2184x1690px.
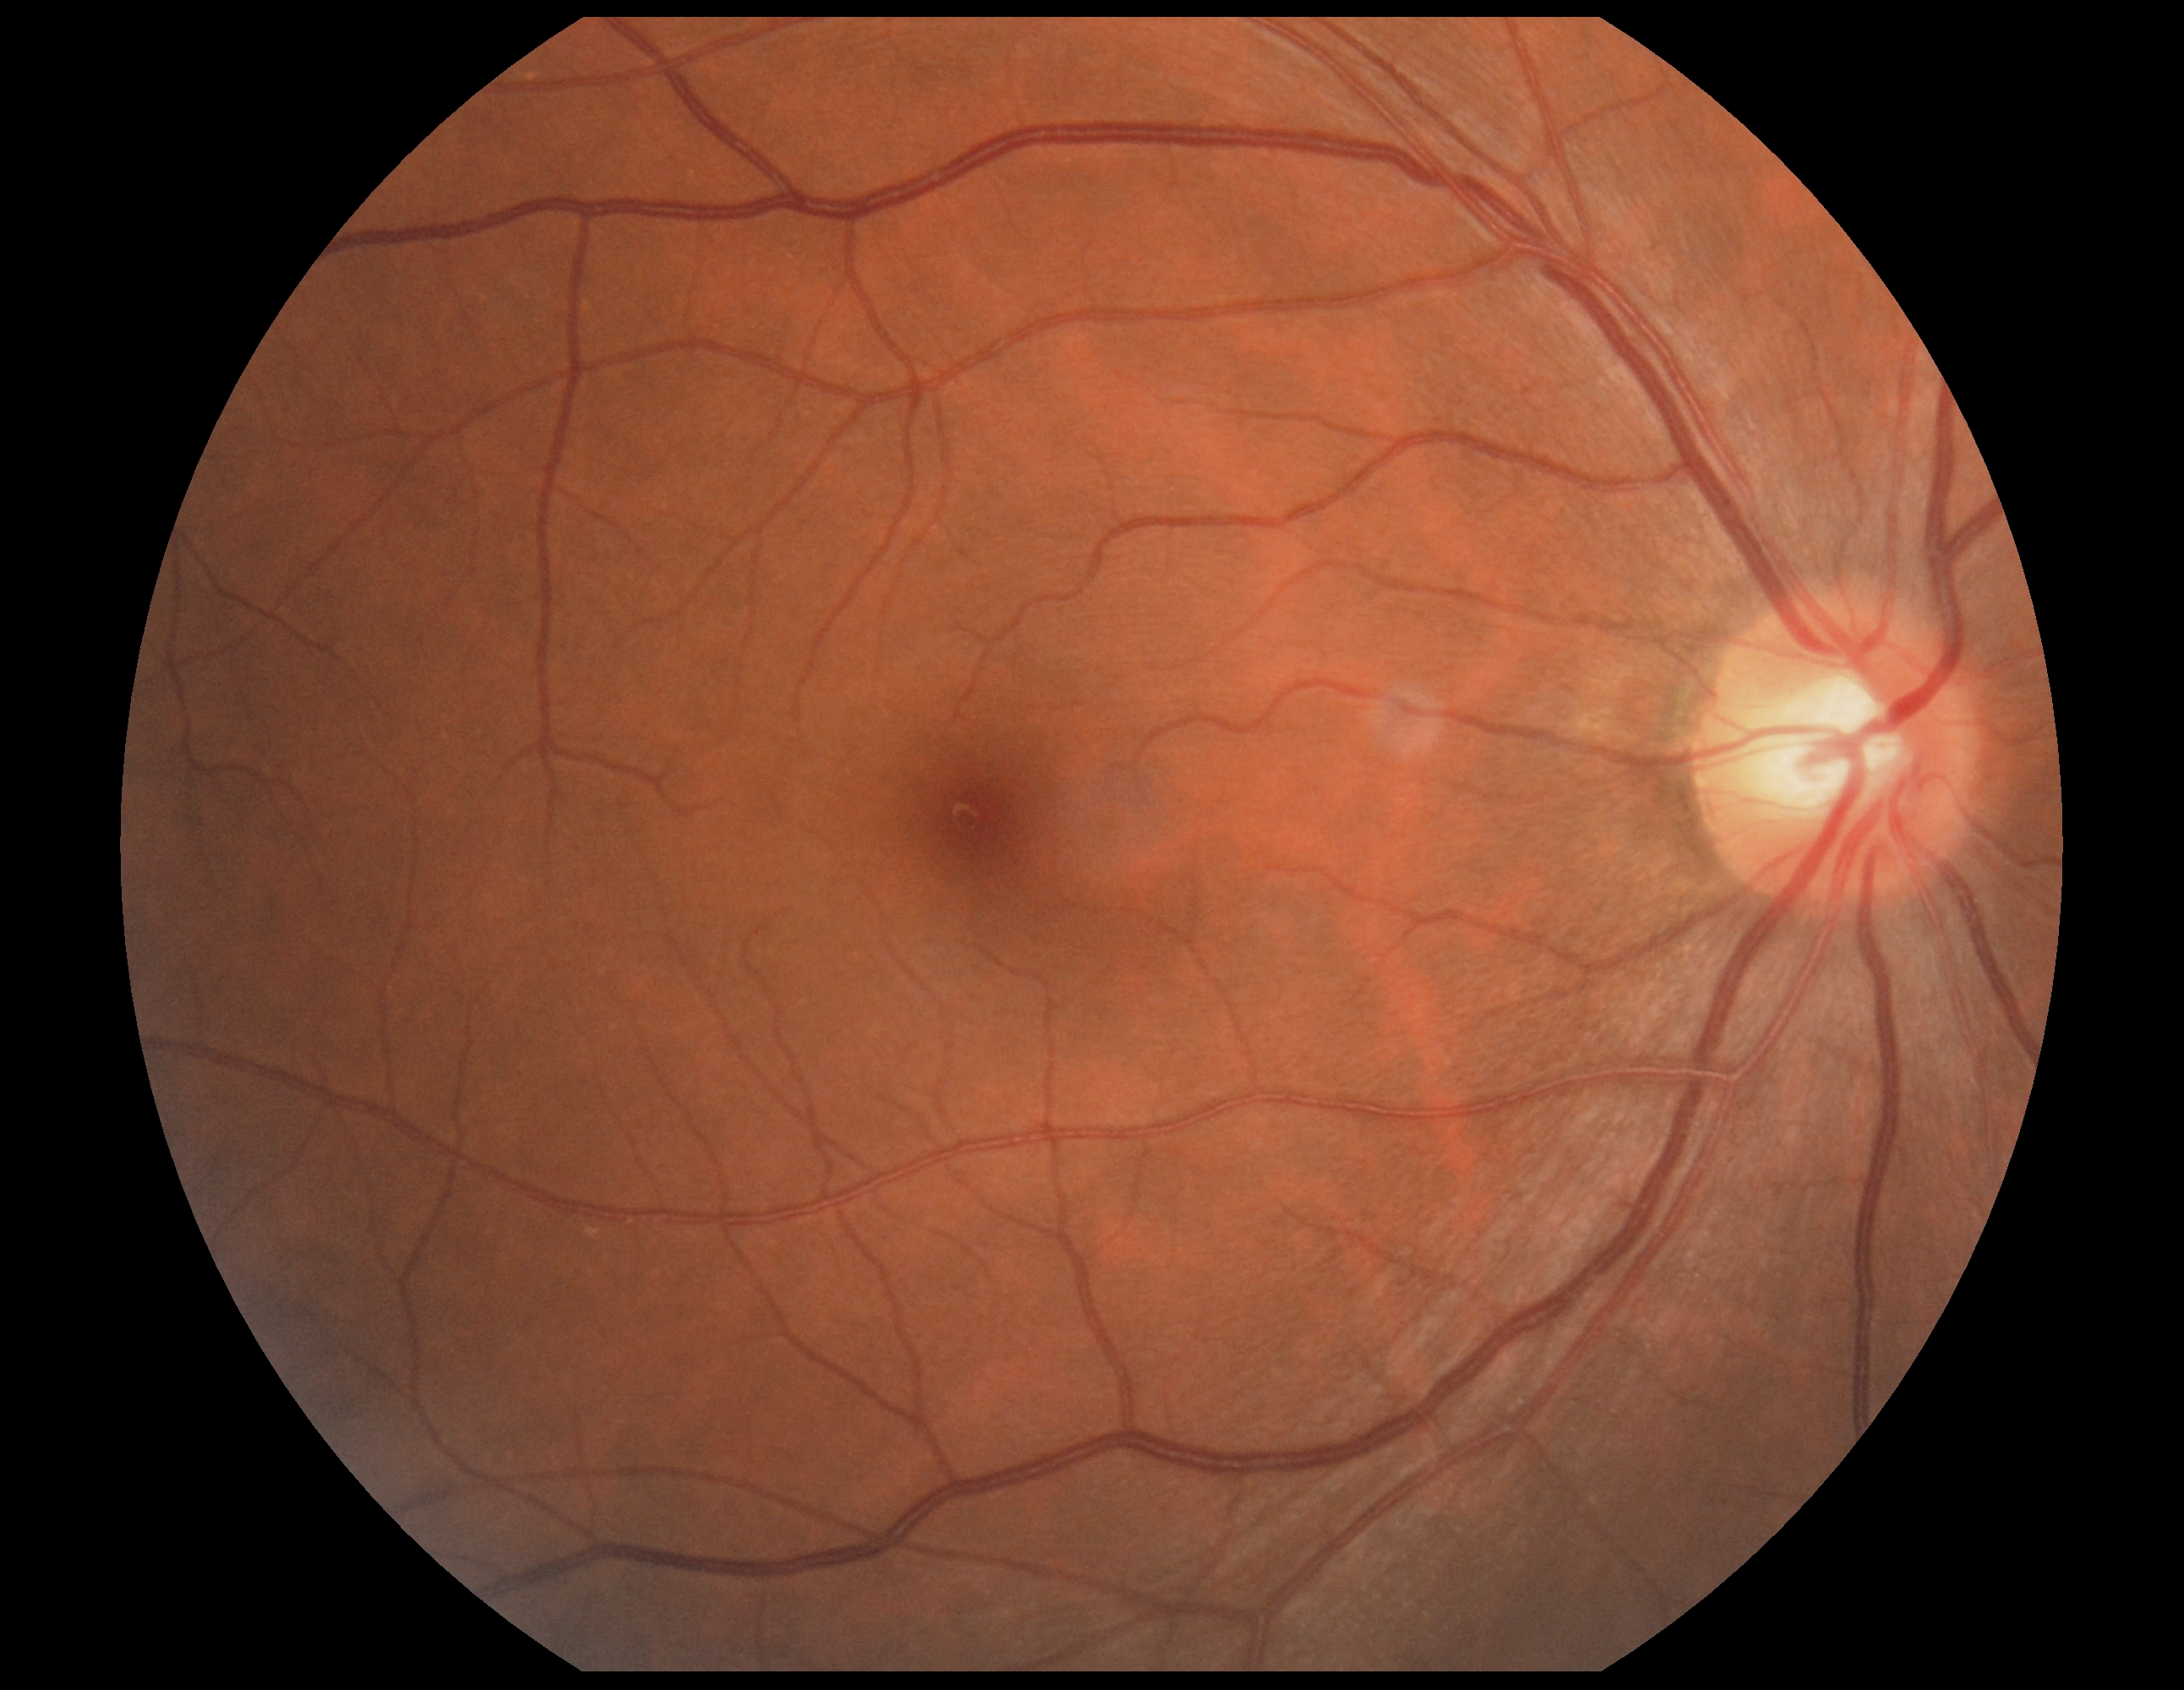

DR impression=no signs of DR, DR=0/4.